Camera: NIDEK AFC-230 · 848x848 · fundus photo — 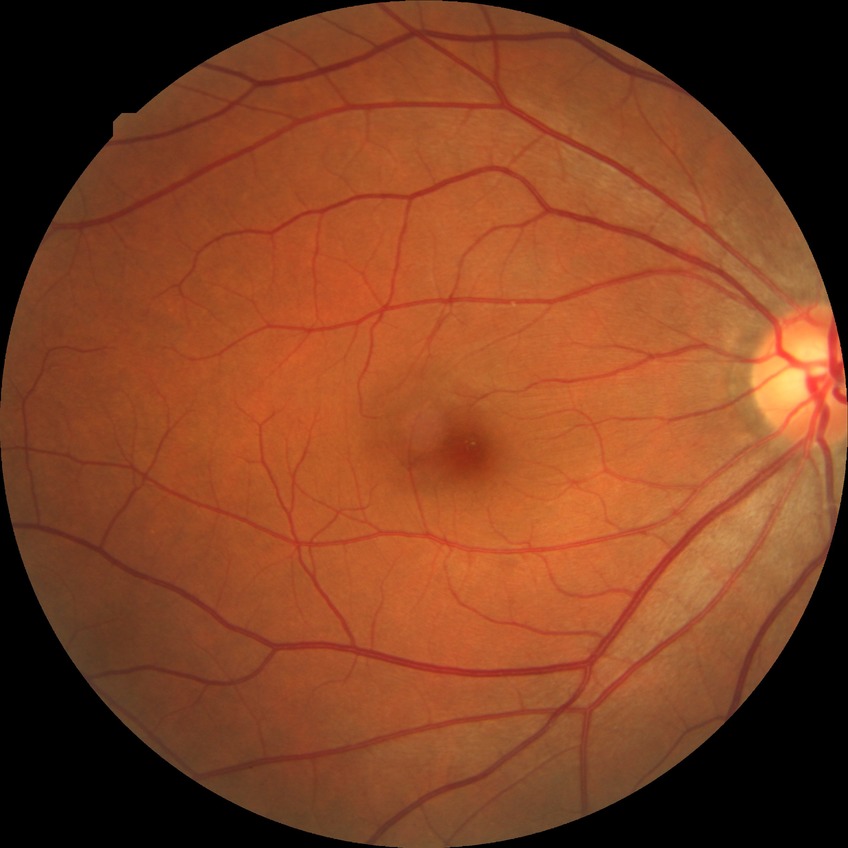

DR stage: NDR. No signs of diabetic retinopathy.